Color fundus image; 45-degree field of view; 2352x1568 — 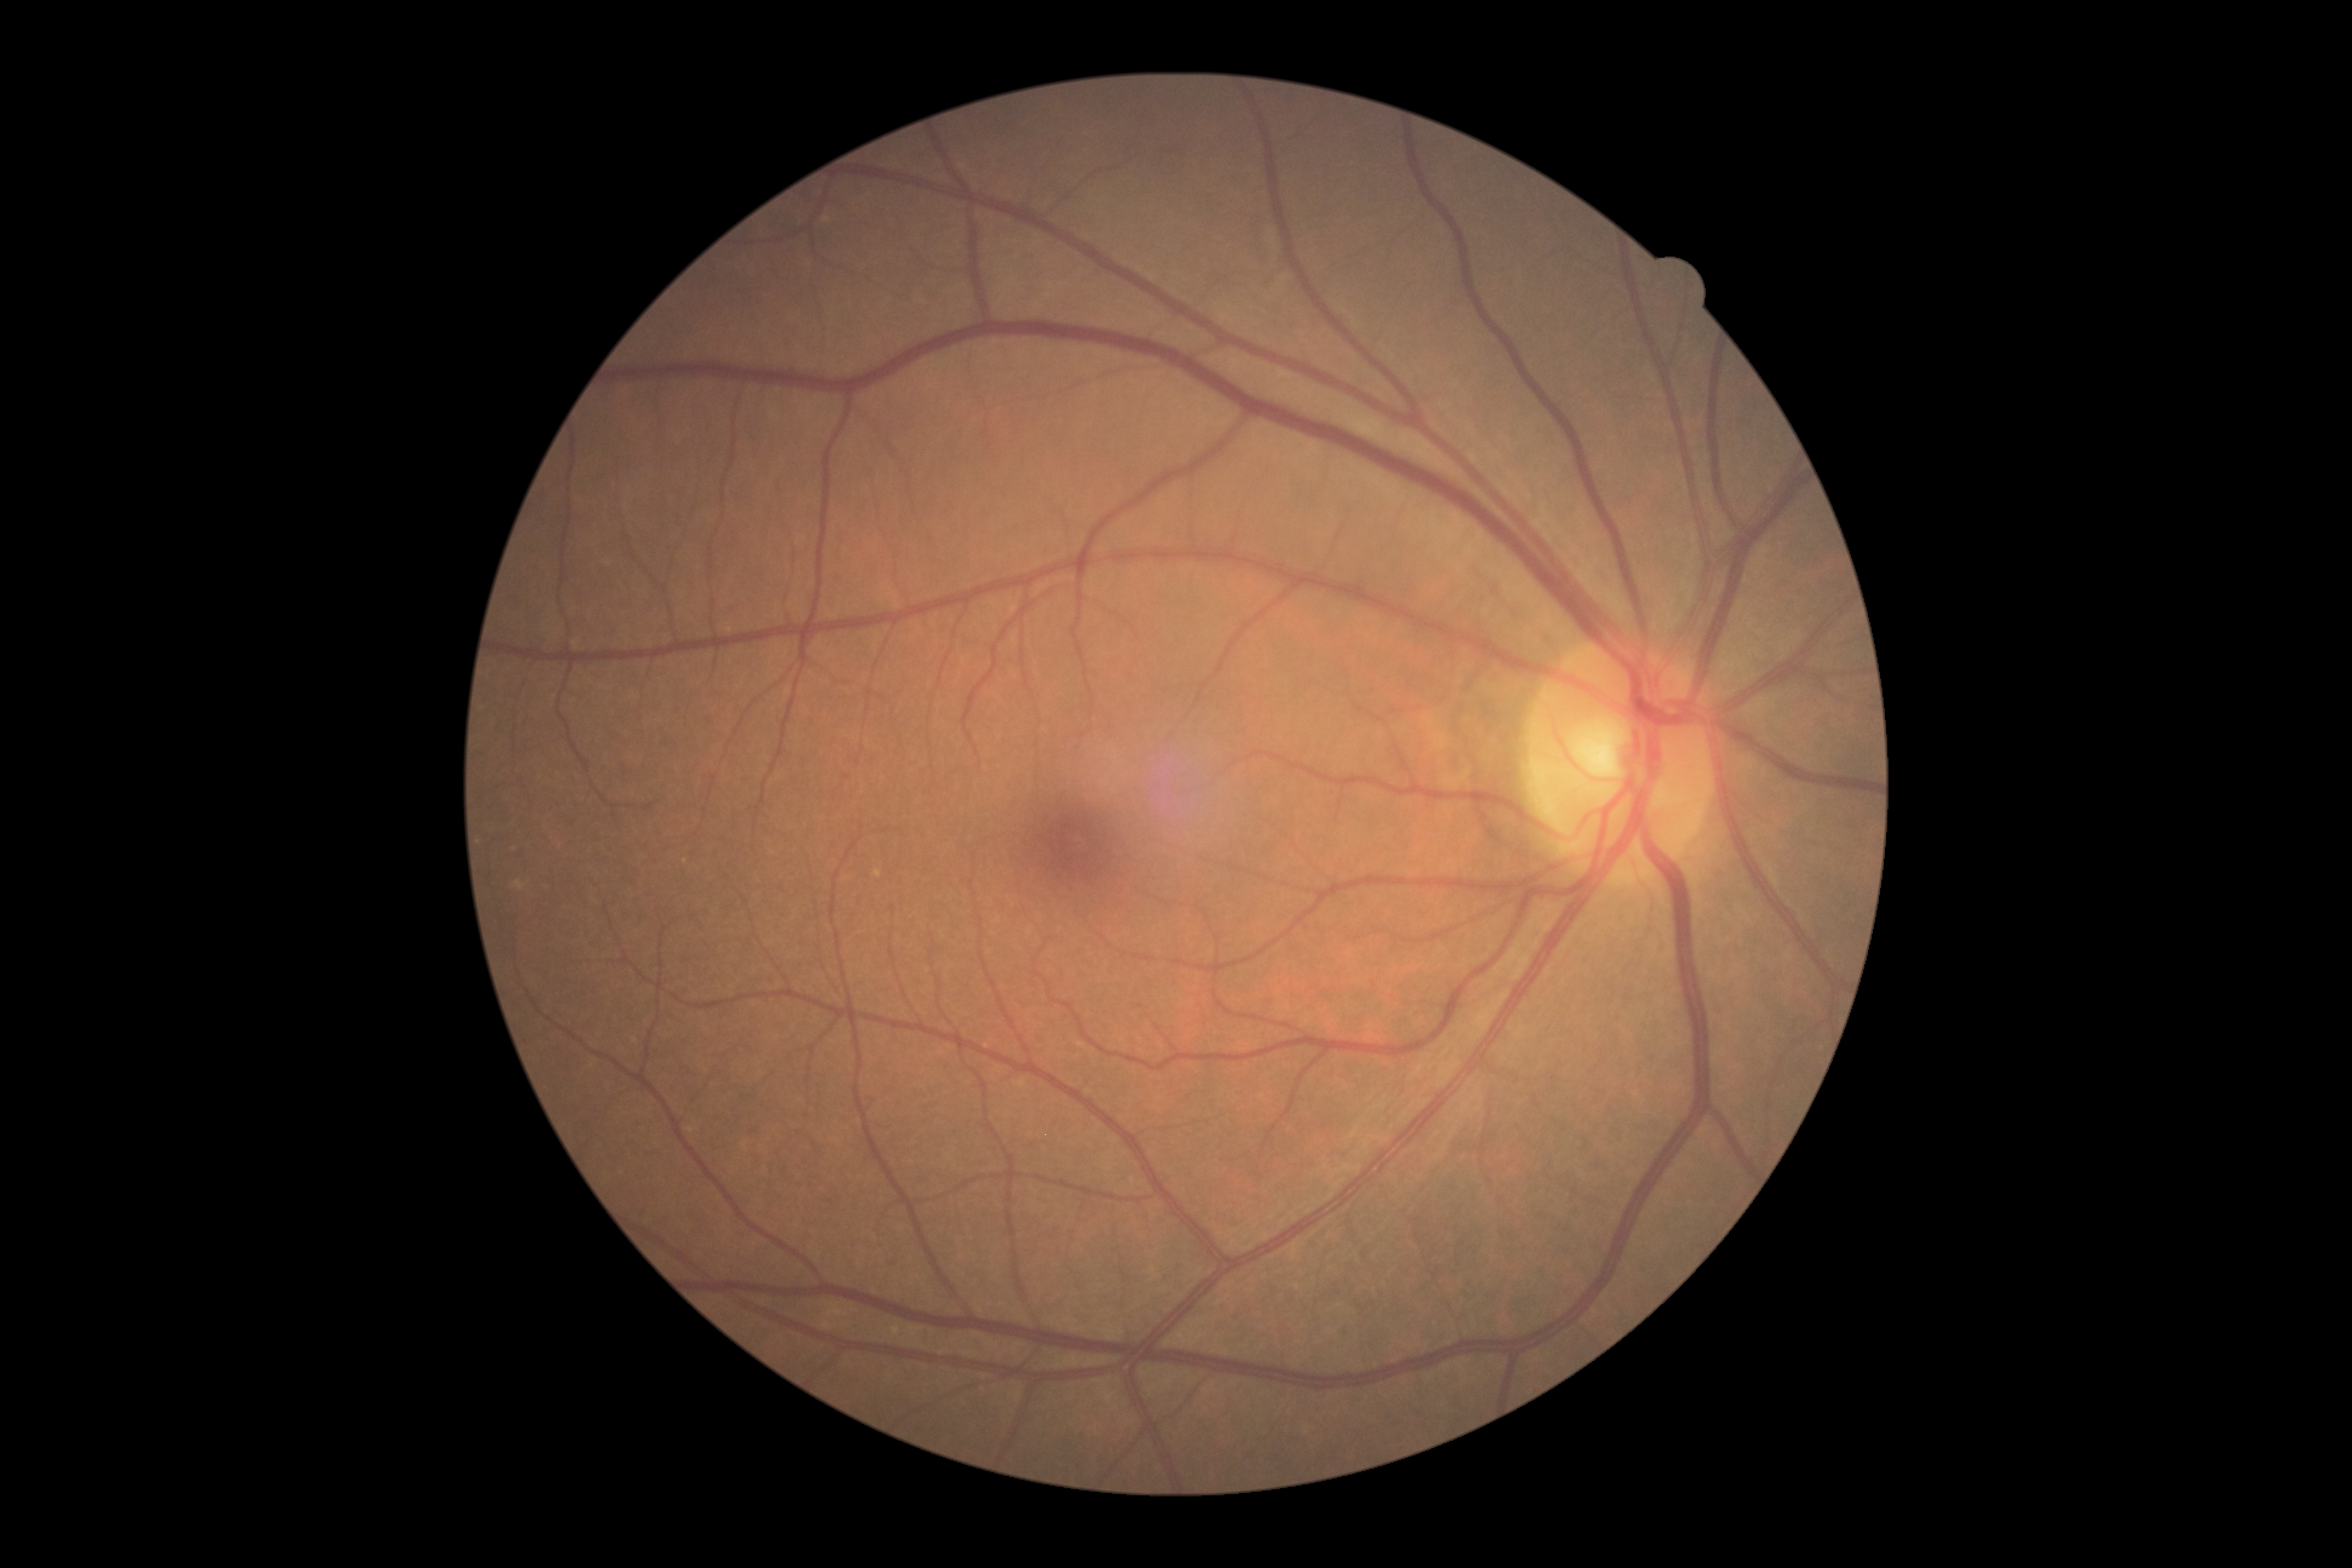
retinopathy: no apparent retinopathy (grade 0).